2352x1568px, color fundus photograph.
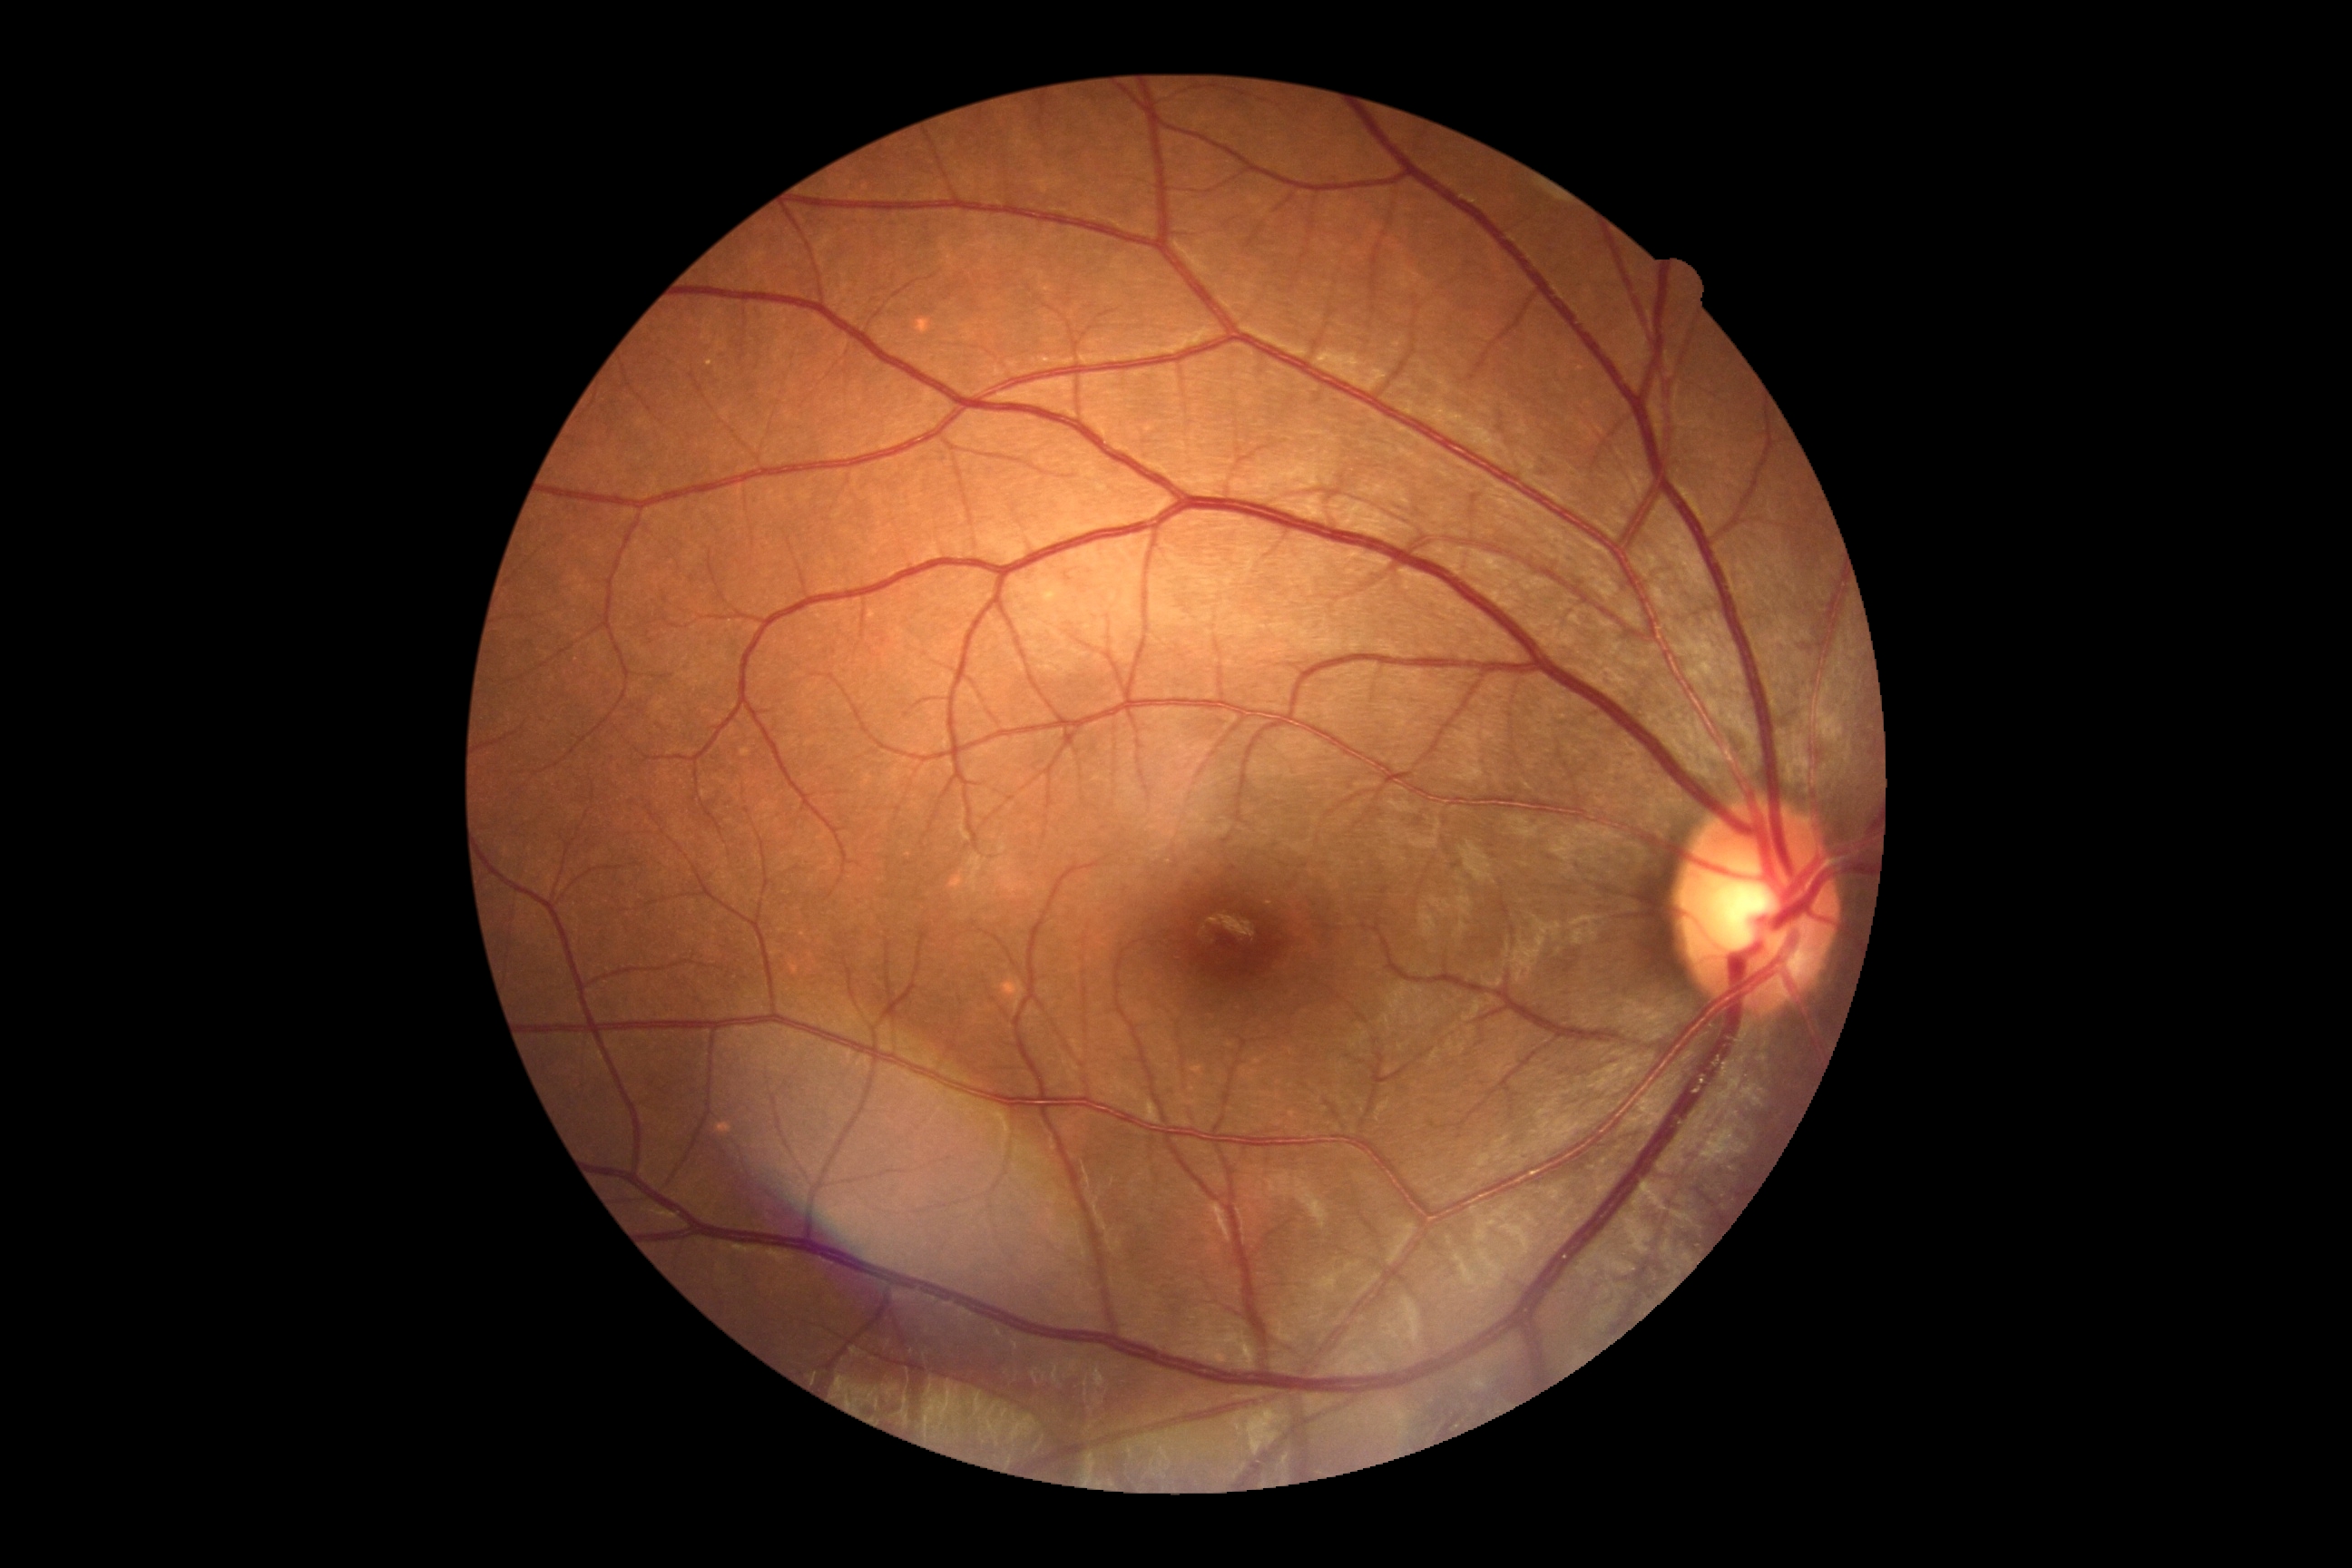
Retinopathy grade: 0. No signs of diabetic retinopathy.